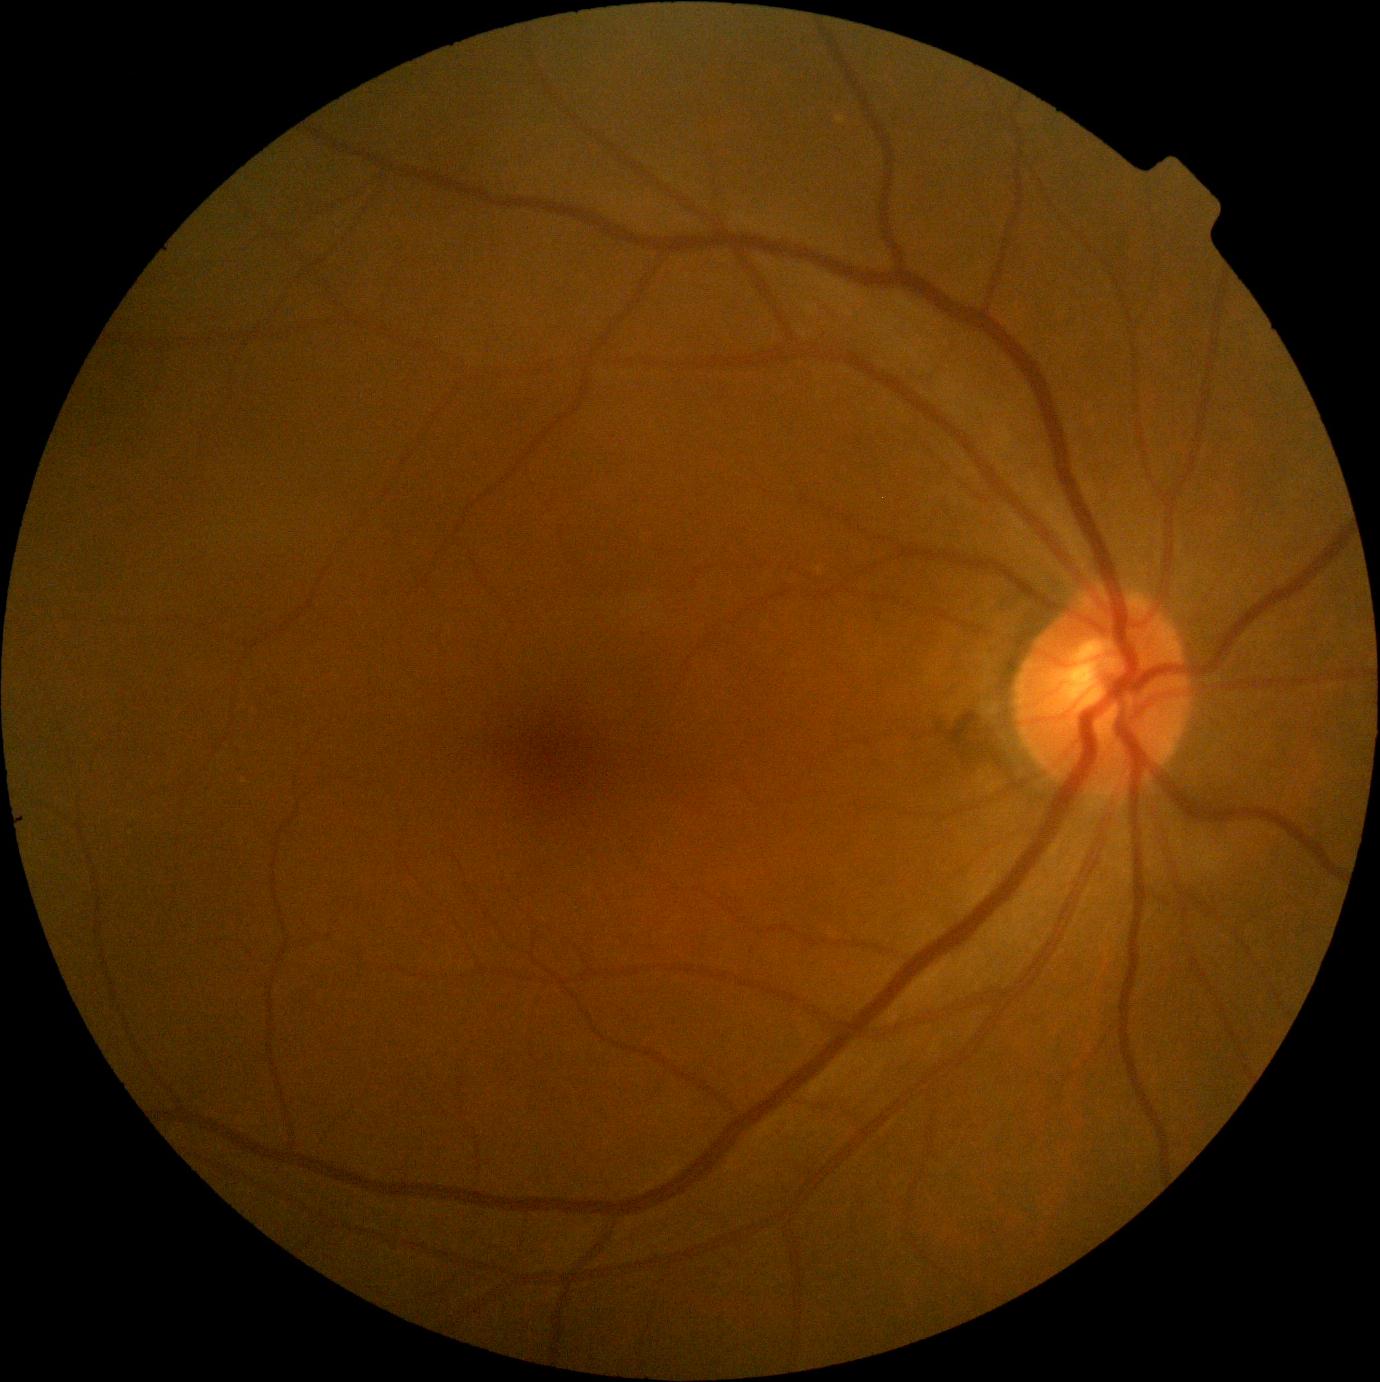

diabetic retinopathy (DR): no apparent retinopathy (grade 0).